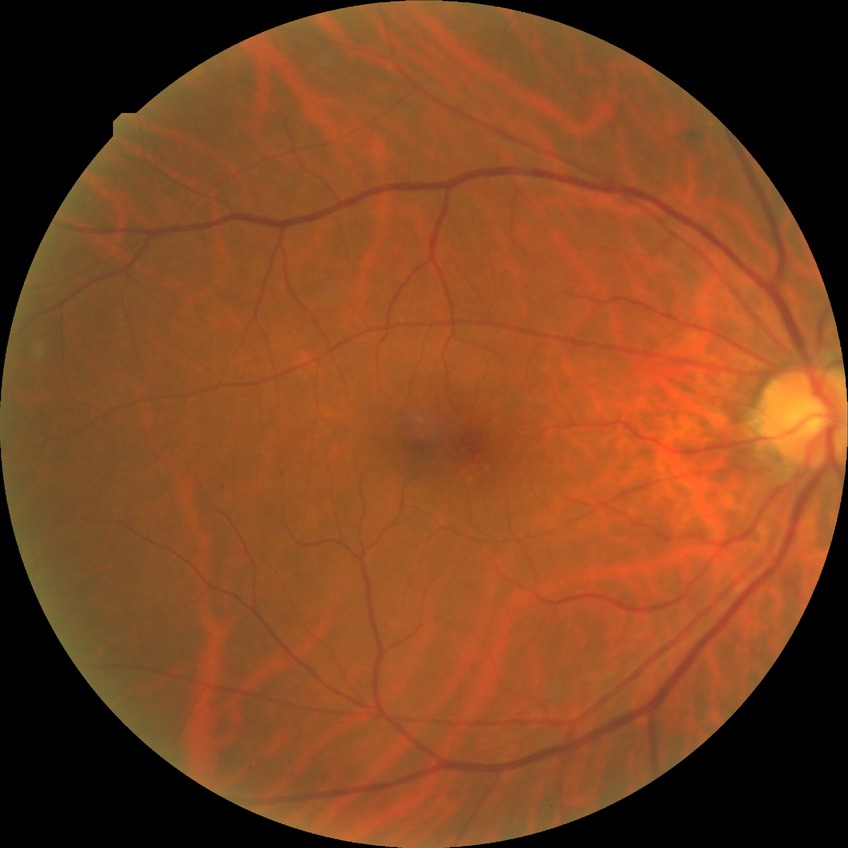 modified Davis grading@no diabetic retinopathy.